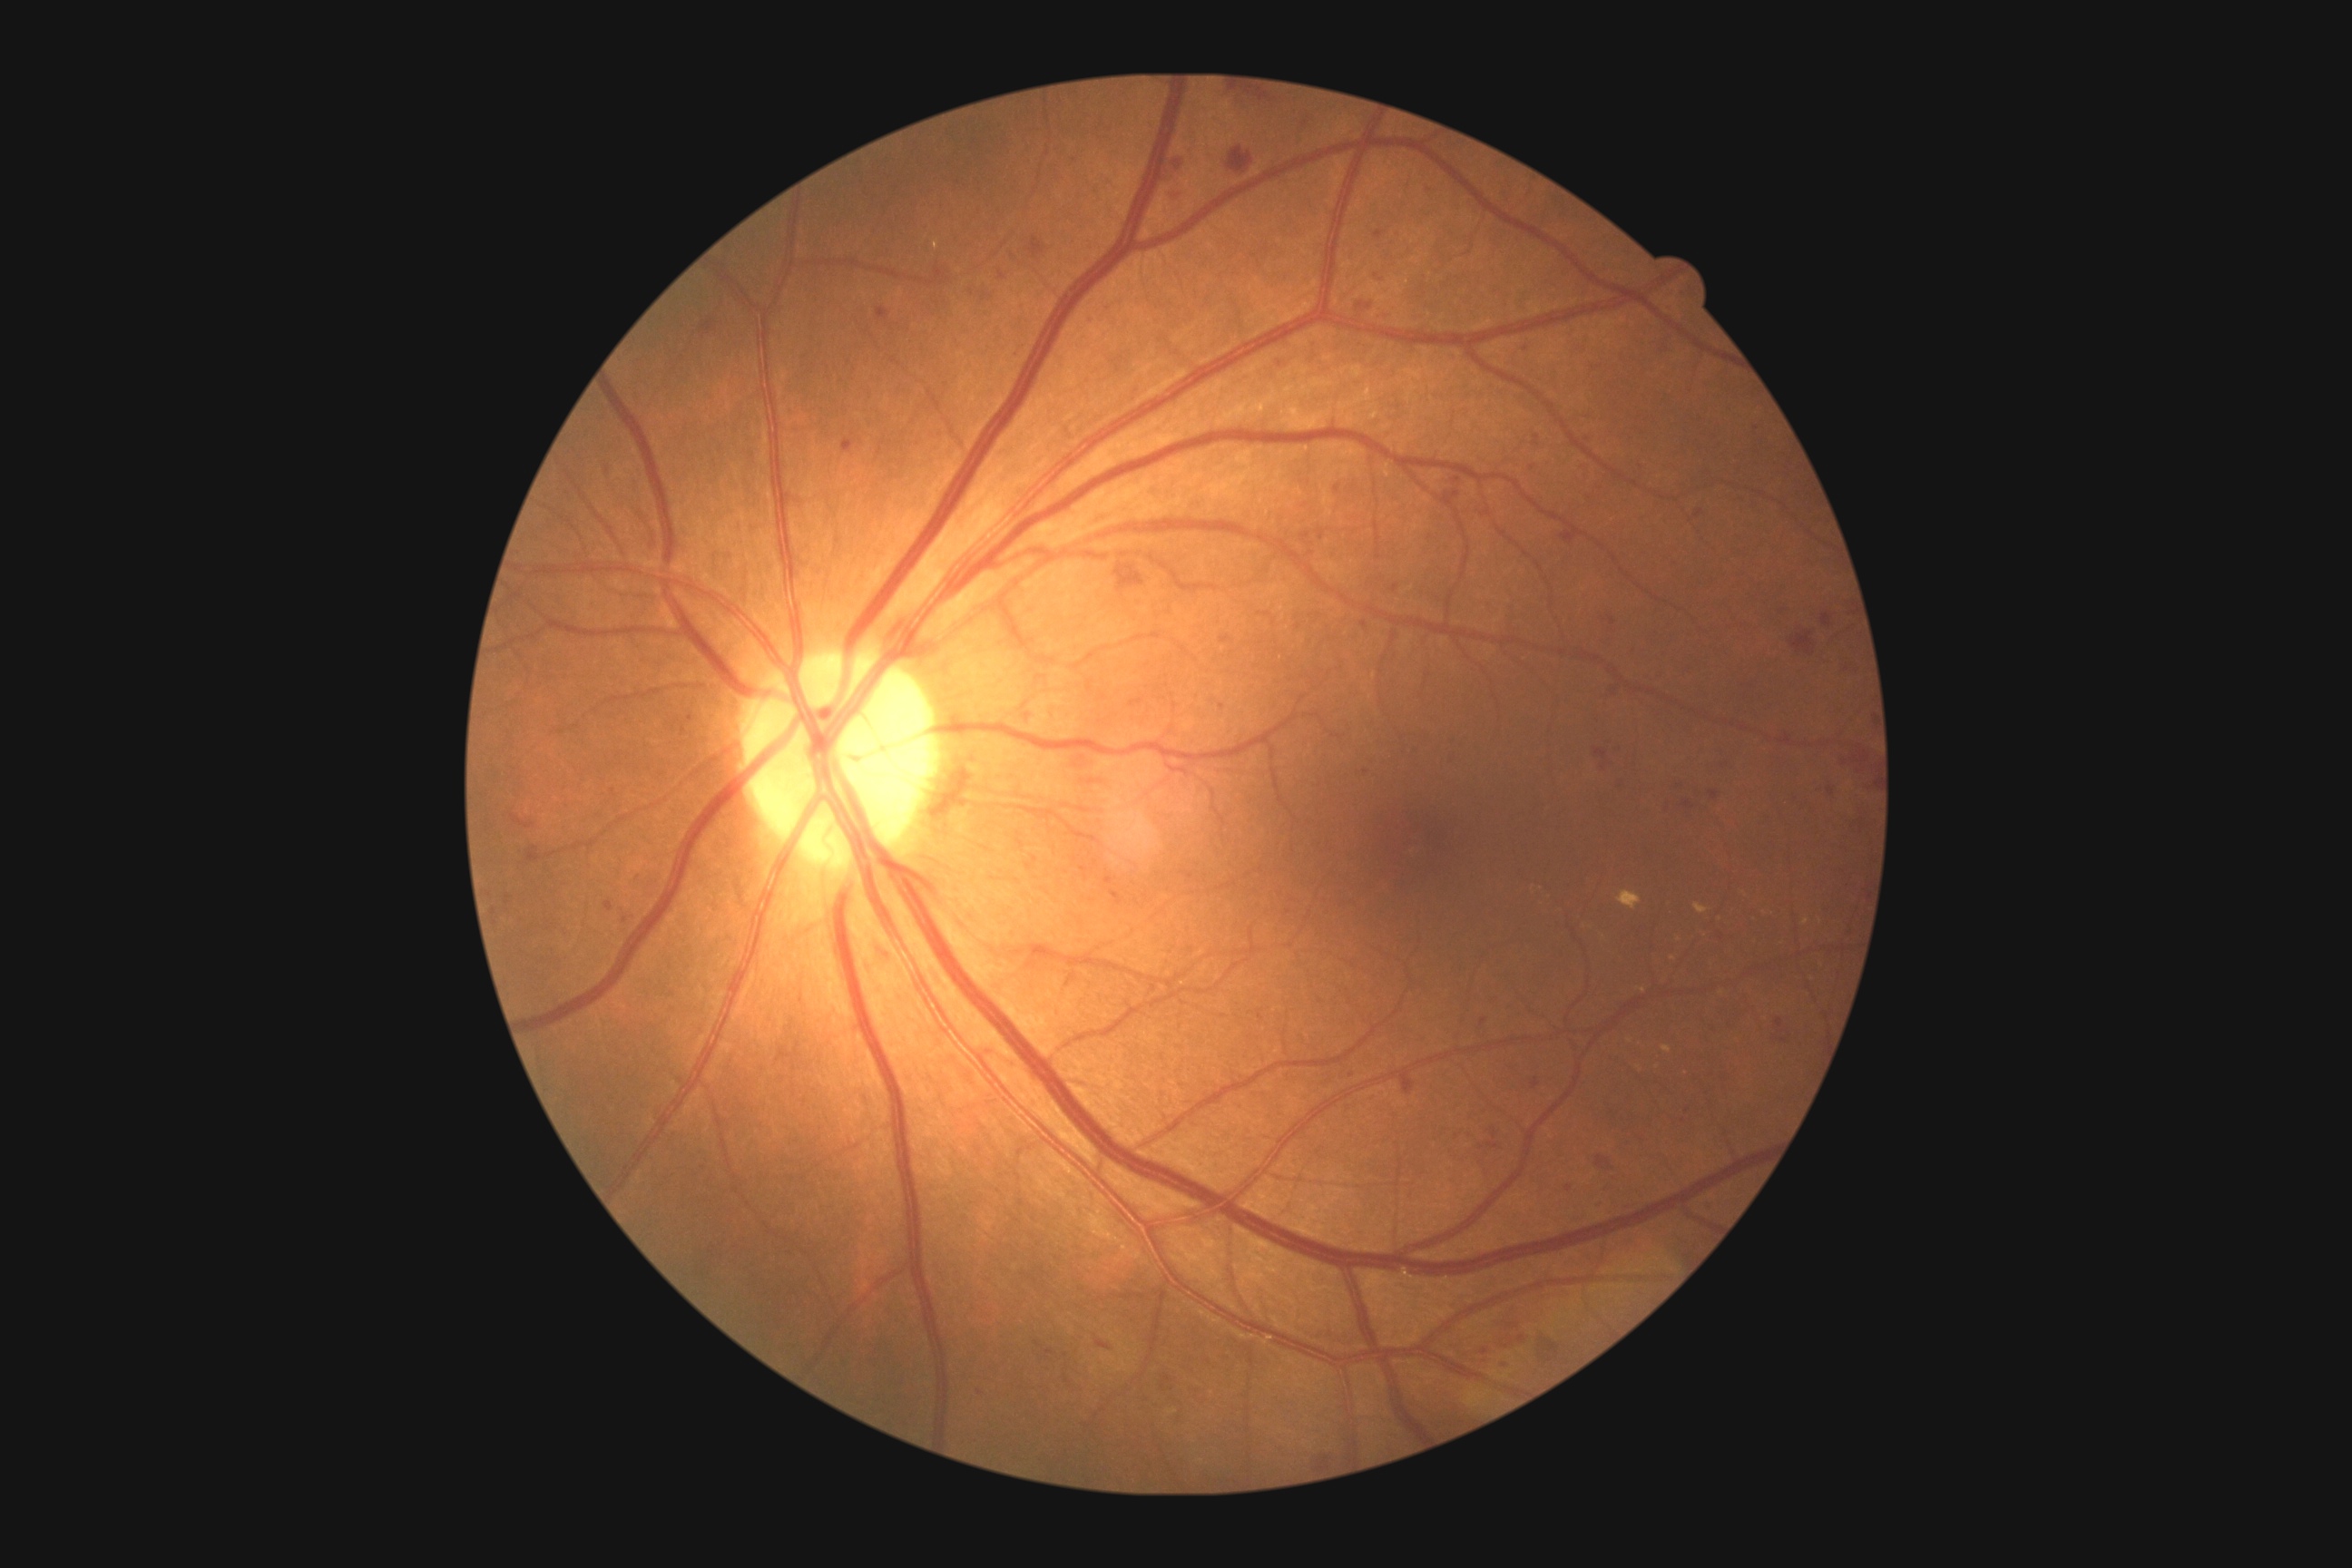 Diabetic retinopathy (DR): grade 2 (moderate NPDR)
Representative lesions:
hemorrhages (HEs) (partial): bbox(1493, 1130, 1498, 1139) | bbox(1295, 108, 1313, 141) | bbox(505, 896, 511, 905) | bbox(1275, 355, 1295, 369) | bbox(1603, 1184, 1612, 1195) | bbox(1035, 1342, 1043, 1348) | bbox(1562, 333, 1591, 357) | bbox(1335, 485, 1342, 495) | bbox(1583, 433, 1596, 442) | bbox(1518, 342, 1533, 353) | bbox(1465, 1106, 1478, 1121) | bbox(1438, 473, 1467, 513) | bbox(1104, 877, 1115, 885) | bbox(1496, 1360, 1511, 1369) | bbox(872, 945, 894, 963) | bbox(1164, 190, 1184, 201)
HEs (small, approximate centers) near 1310:553 | 972:292 | 1075:160